1920x1088:
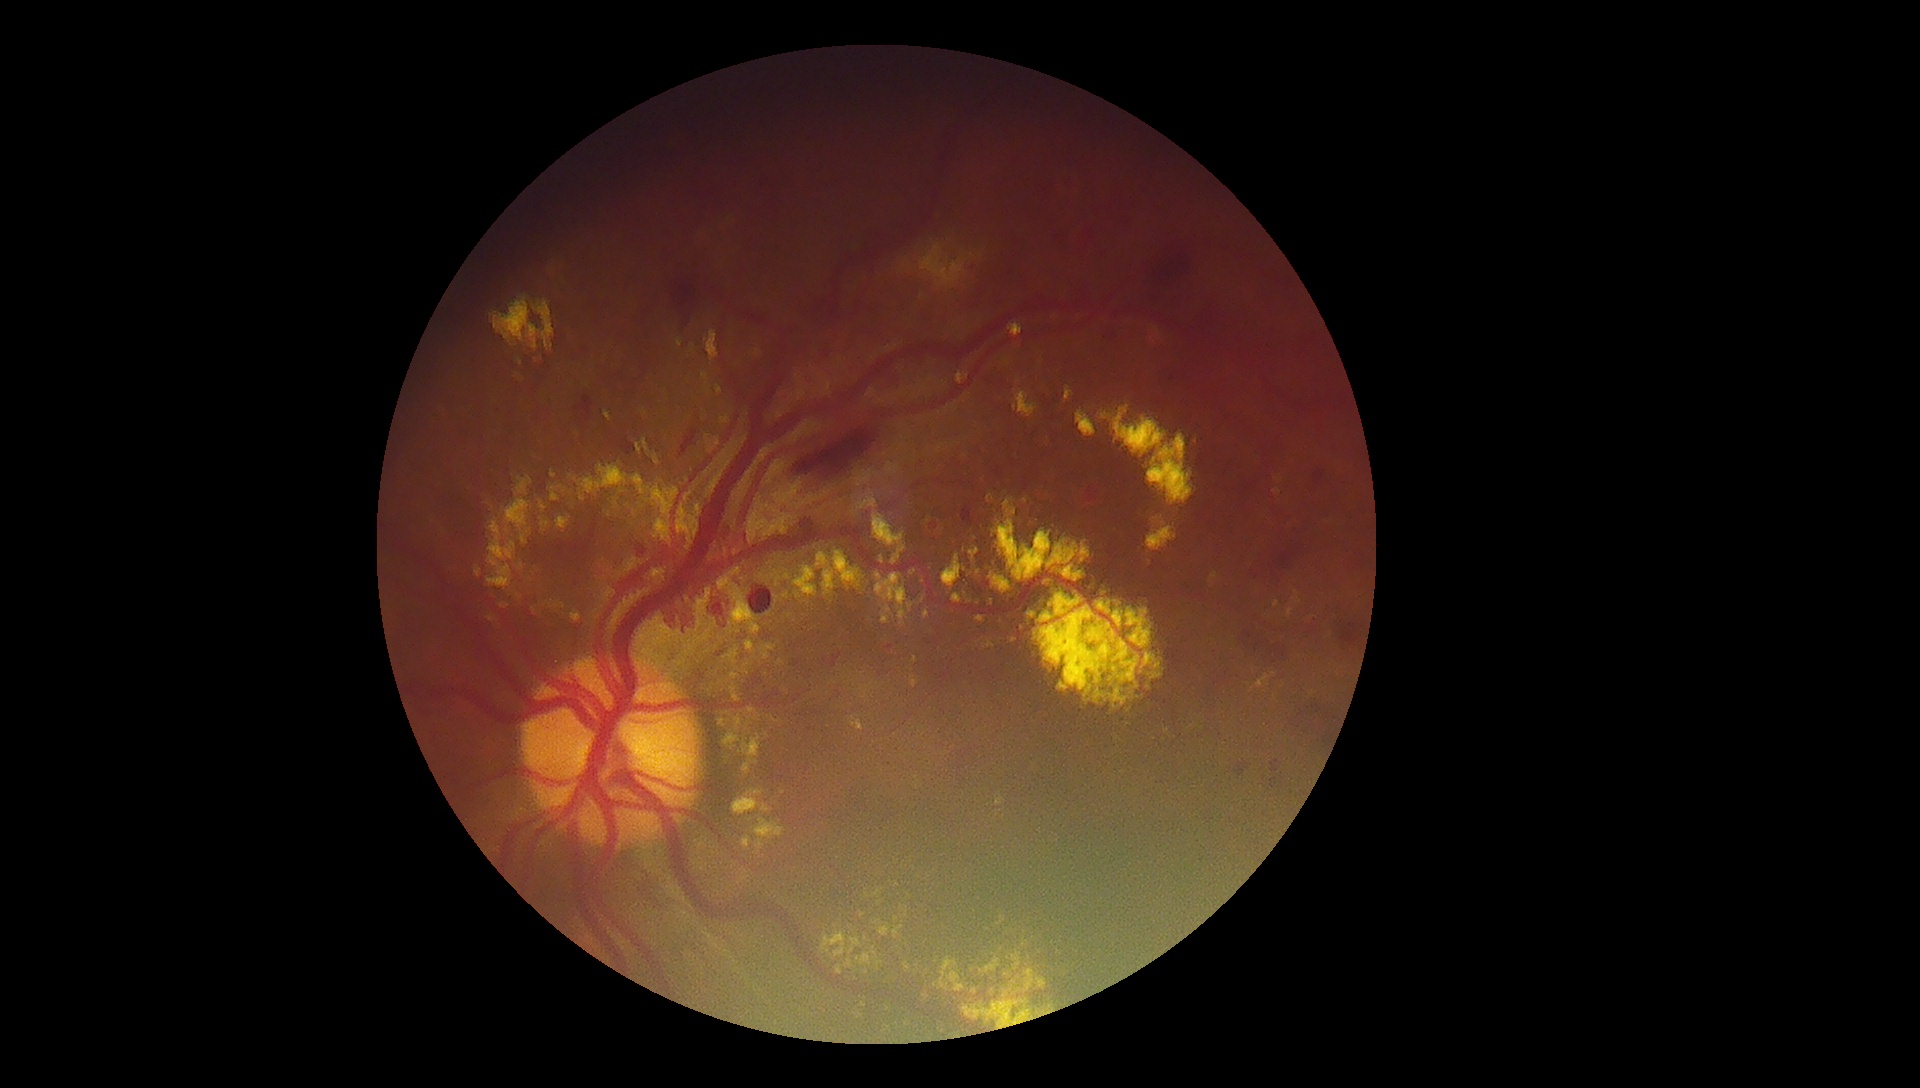

DR grade: PDR (4)
Selected lesions:
EXs (continued): bbox=[845, 959, 854, 969], bbox=[956, 371, 969, 384], bbox=[475, 567, 482, 578], bbox=[755, 818, 786, 850], bbox=[748, 522, 762, 544], bbox=[571, 611, 581, 623], bbox=[551, 470, 557, 479], bbox=[882, 606, 894, 625], bbox=[500, 603, 510, 609], bbox=[968, 564, 1019, 599], bbox=[821, 933, 847, 958]
Smaller EXs around (975; 538), (937; 960), (710; 690), (927; 971), (622; 492), (521; 362), (859; 585)